Pediatric retinal photograph (wide-field) · 100° field of view (Phoenix ICON) · 1240 x 1240 pixels:
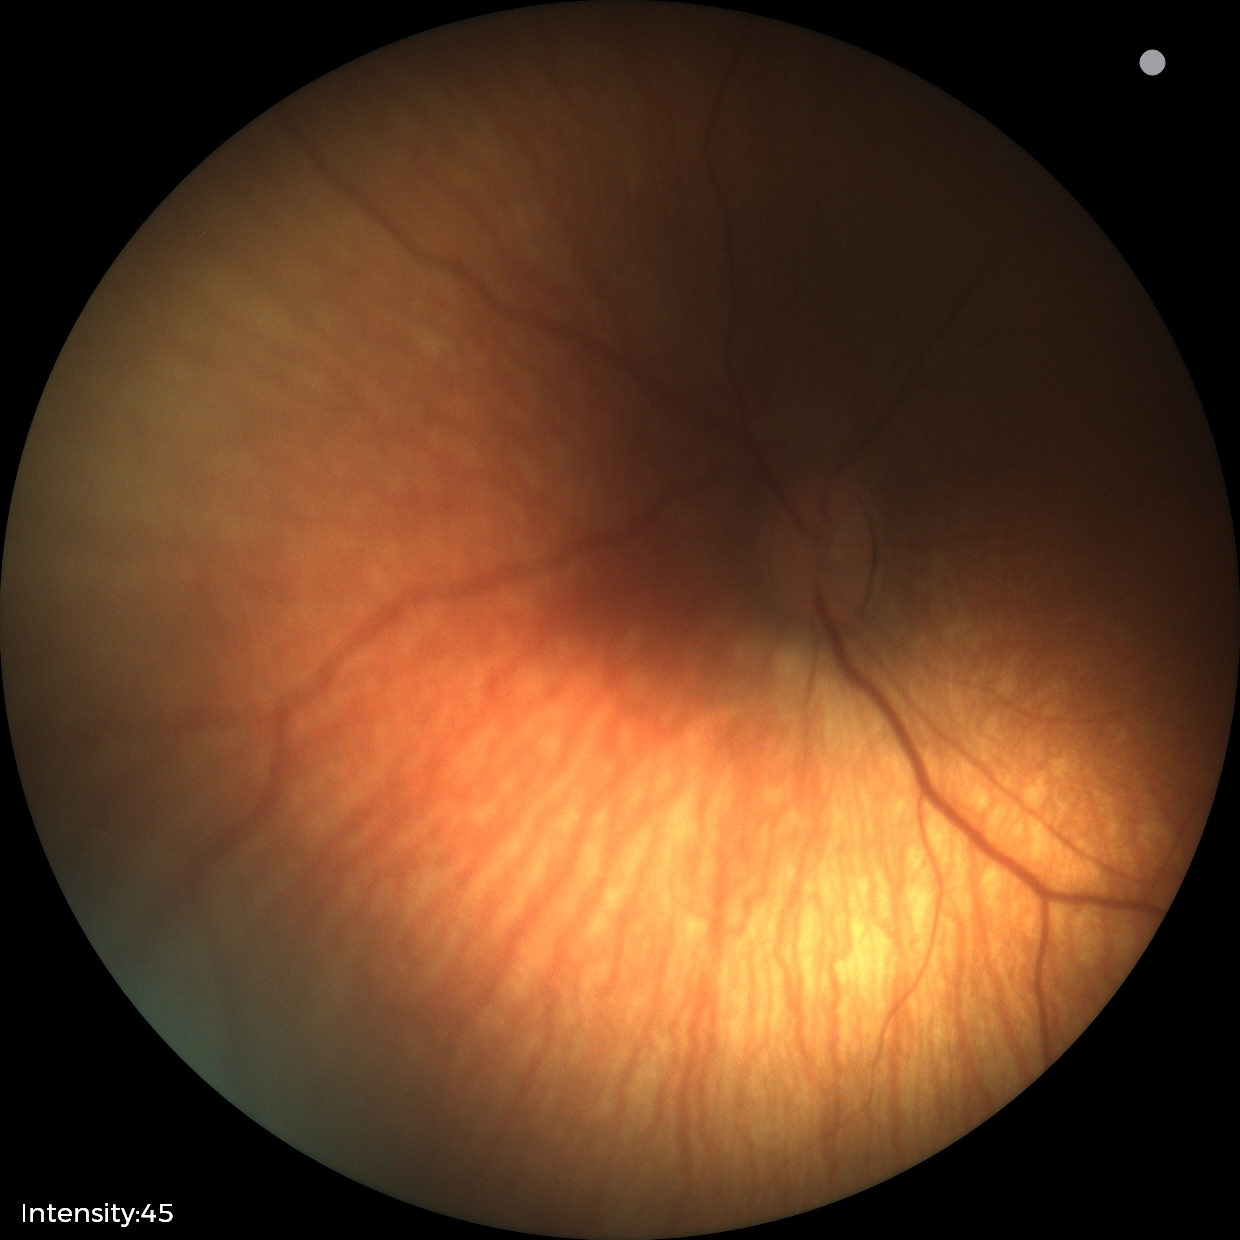 Impression: physiological appearance with no retinal pathology.